Fundus image cropped to the optic disc: 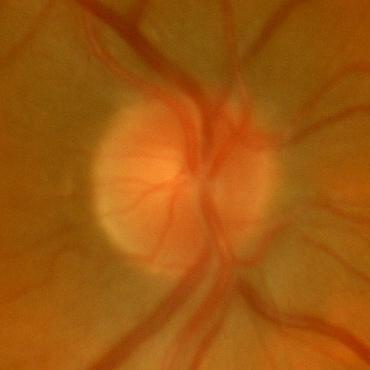

No signs of glaucoma.